Pediatric retinal photograph (wide-field); 130° field of view (Natus RetCam Envision); 1440x1080:
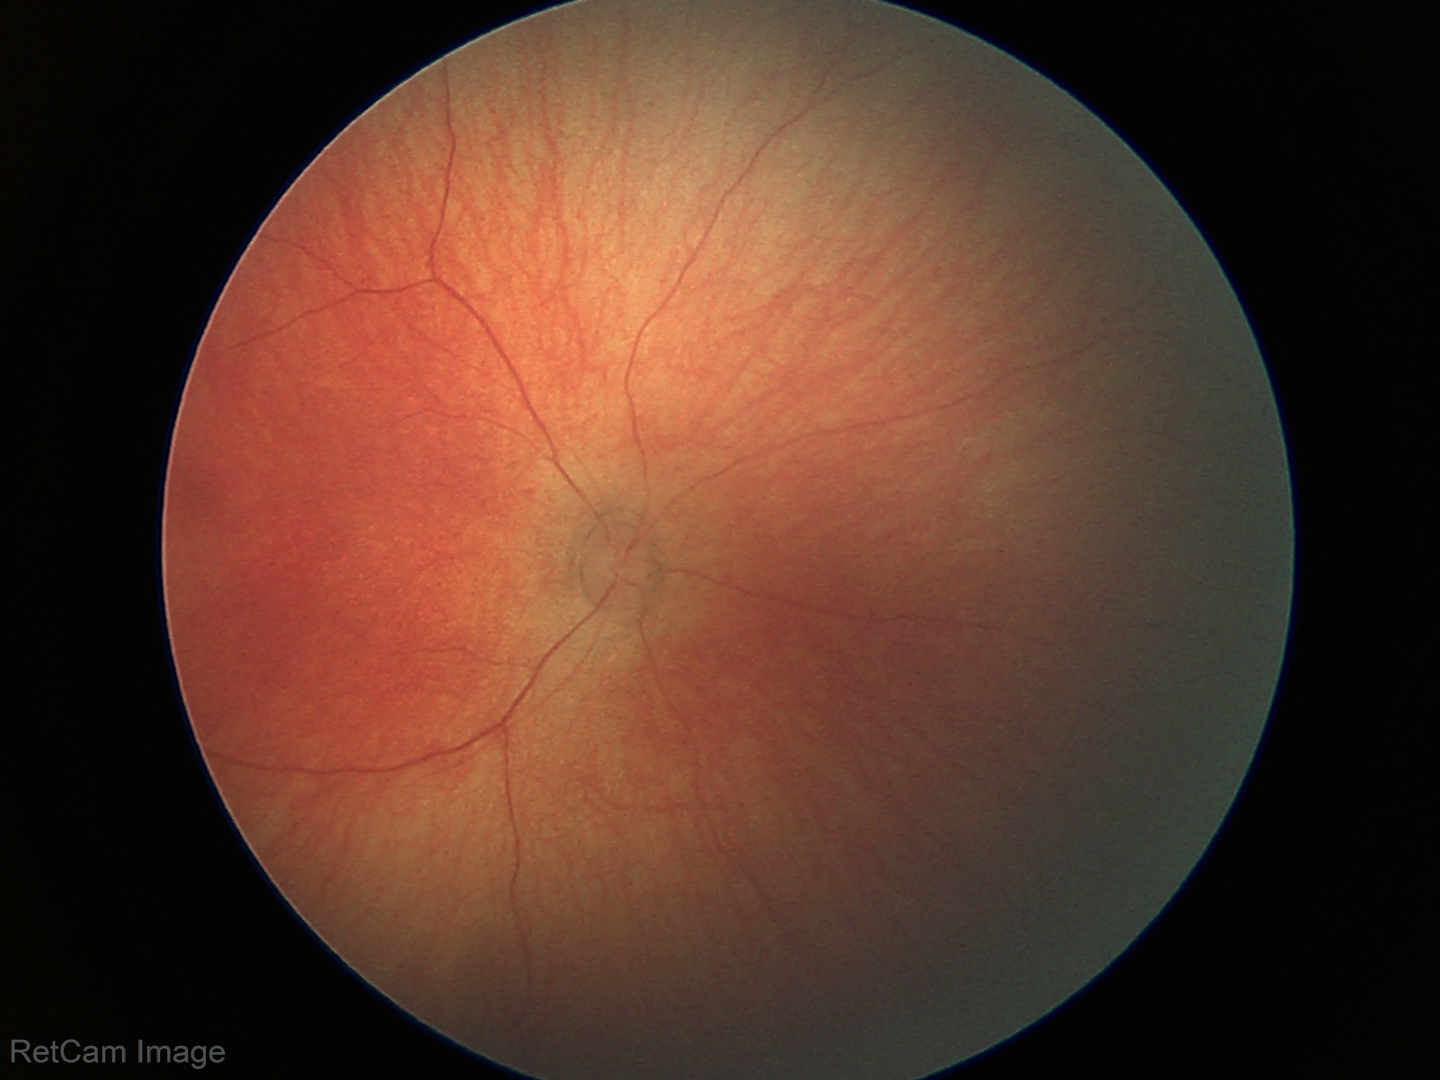 No retinal pathology identified on screening.